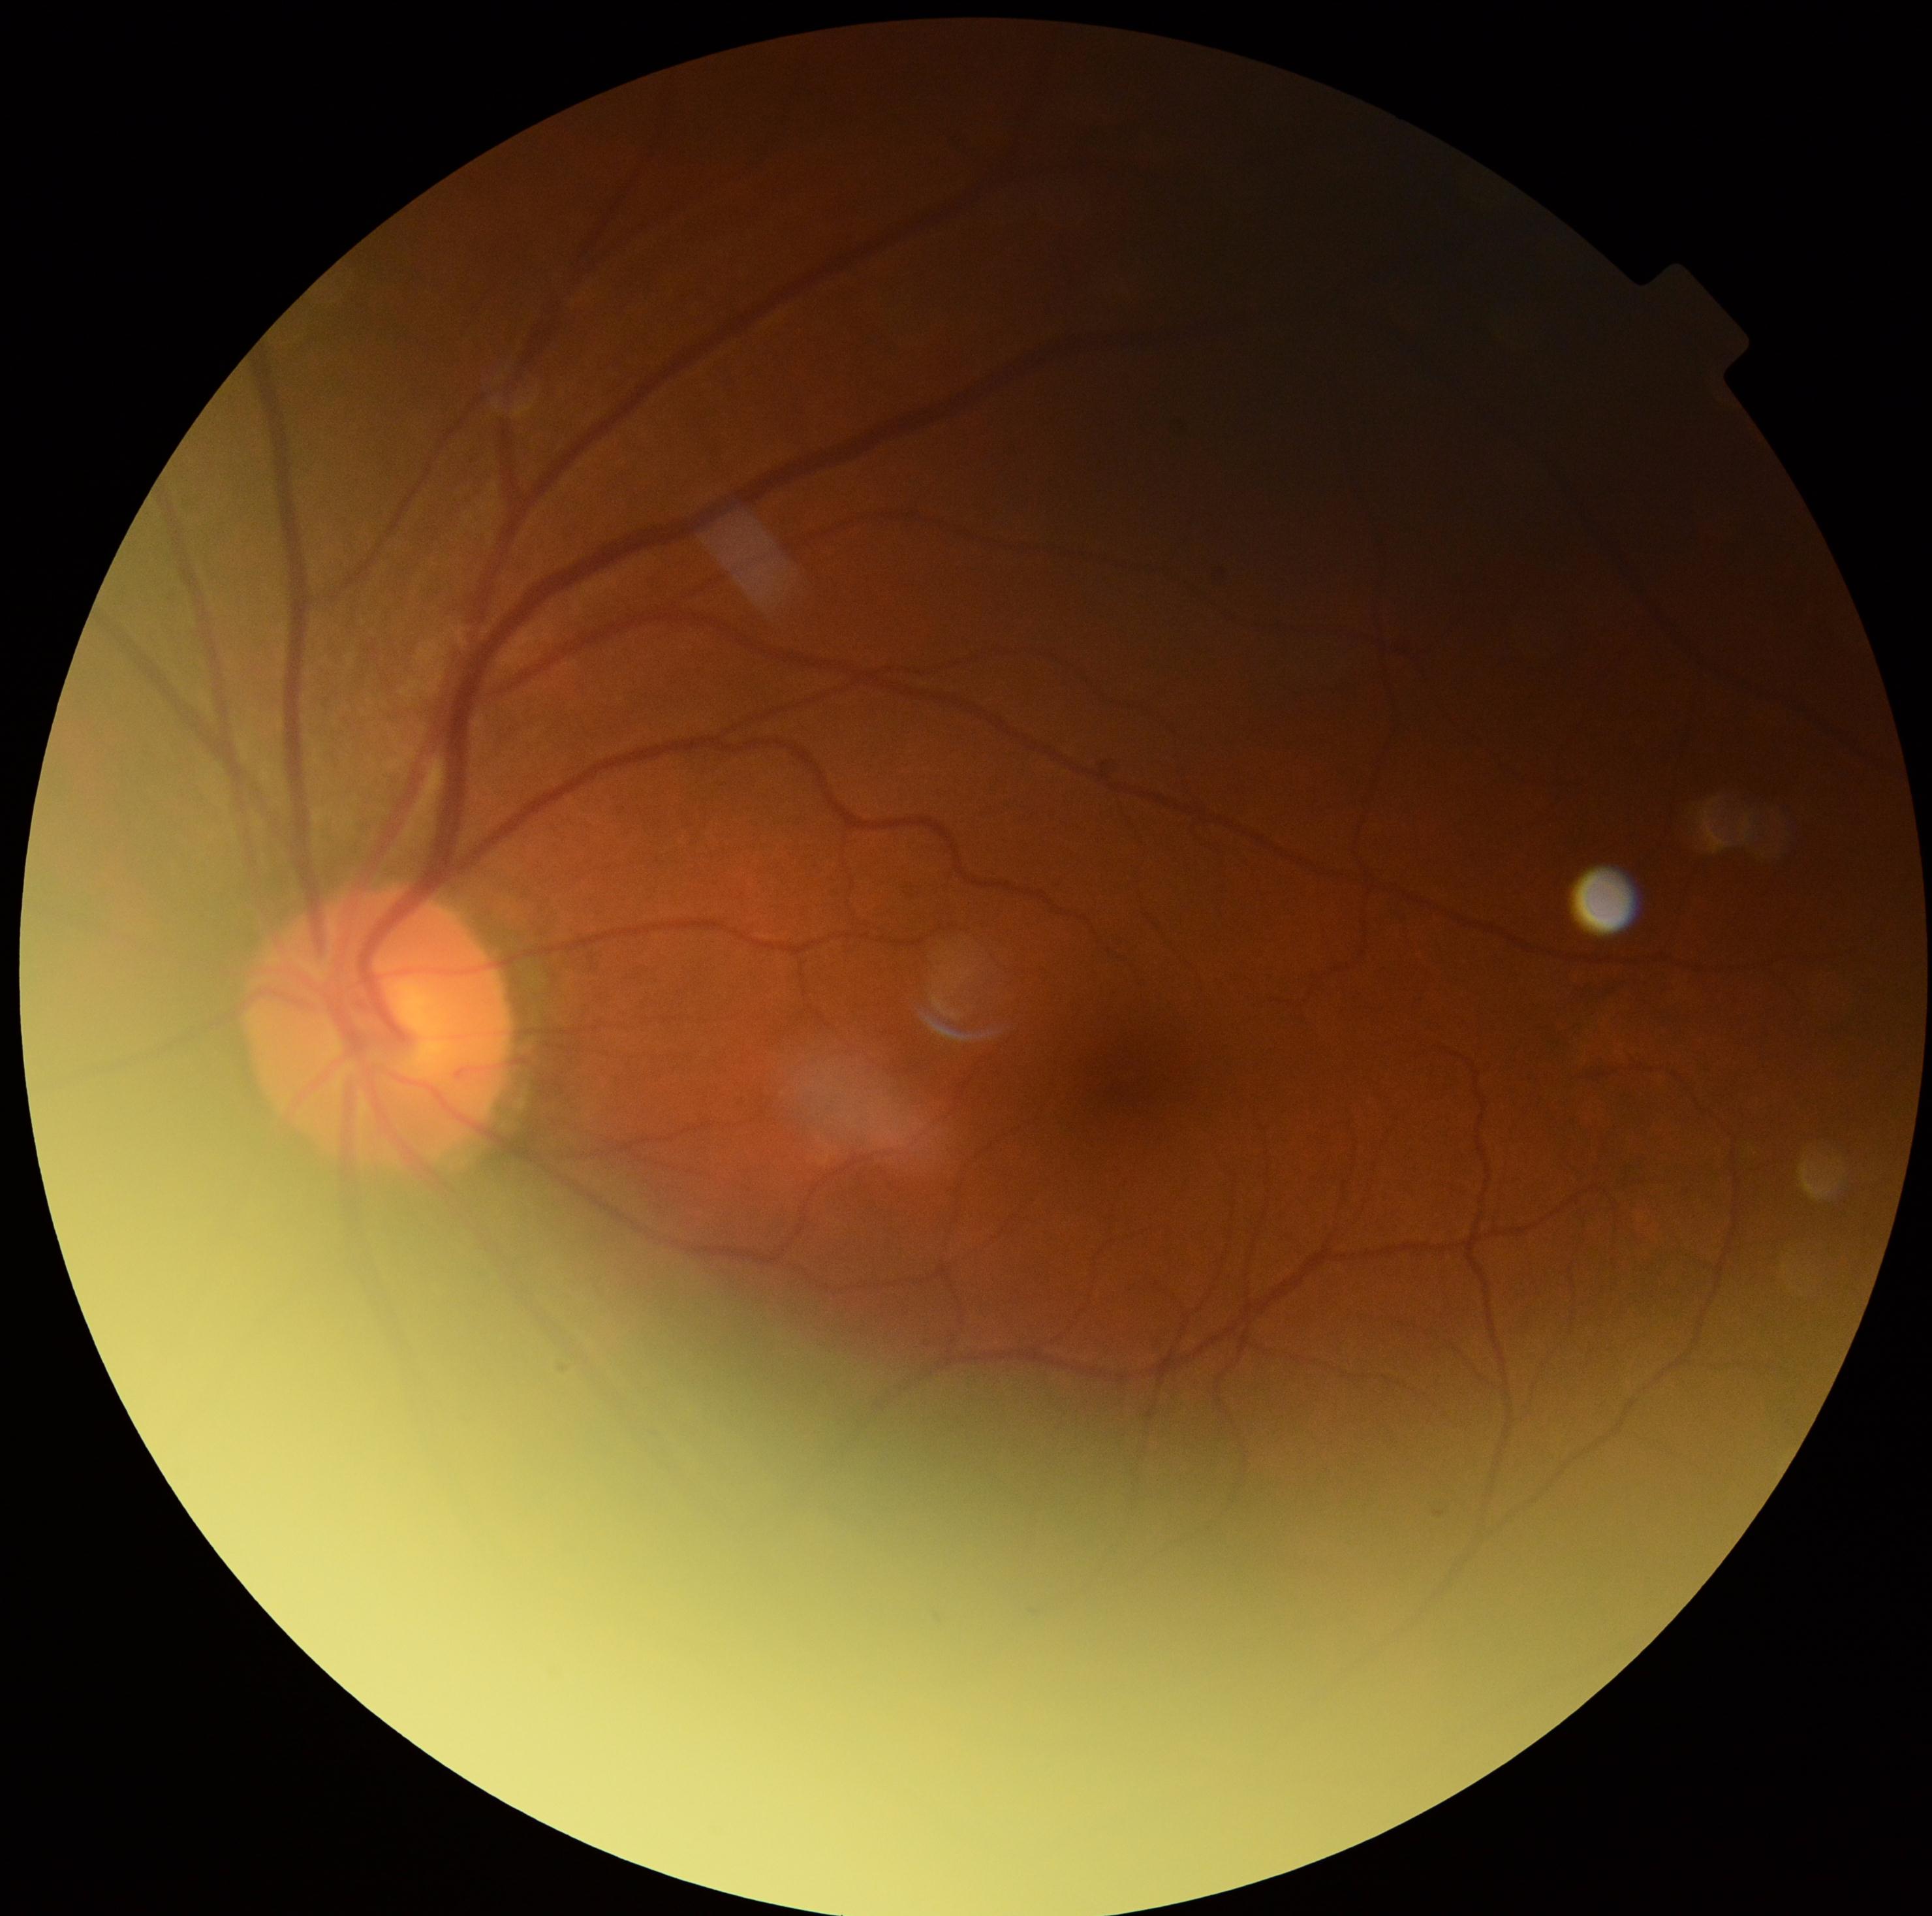
No signs of diabetic retinopathy. Retinopathy grade is 0 (no apparent retinopathy).